Image size 1240x1240 · captured with the Phoenix ICON (100° field of view) · pediatric wide-field fundus photograph:
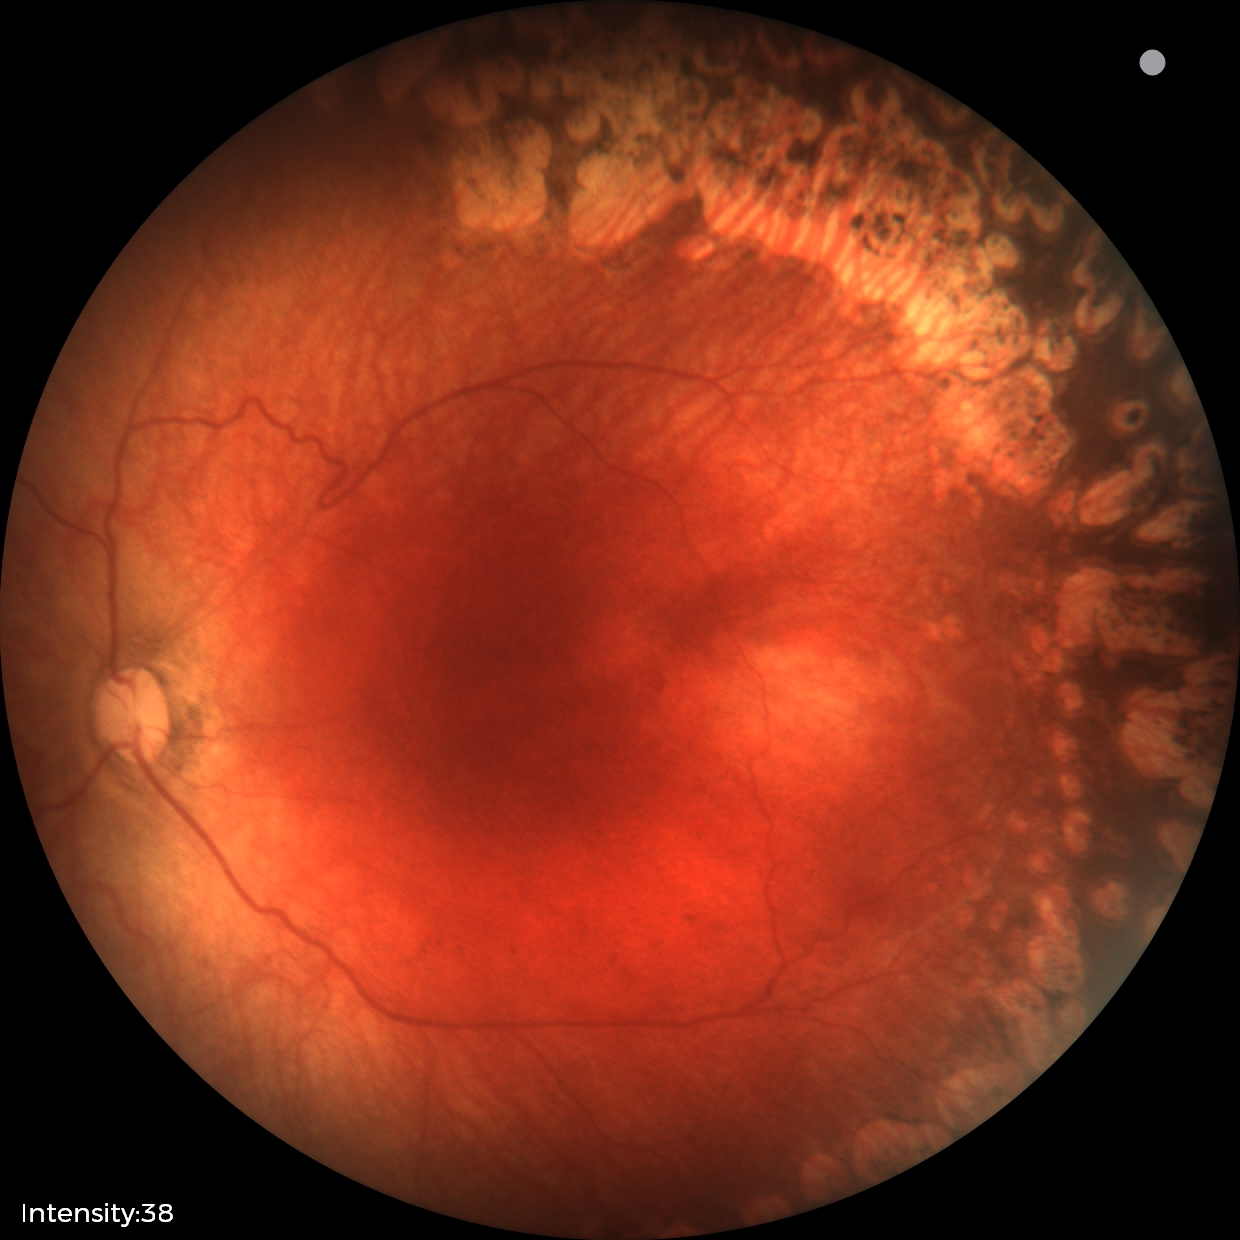

Plus disease absent.
Screening examination consistent with status post ROP.